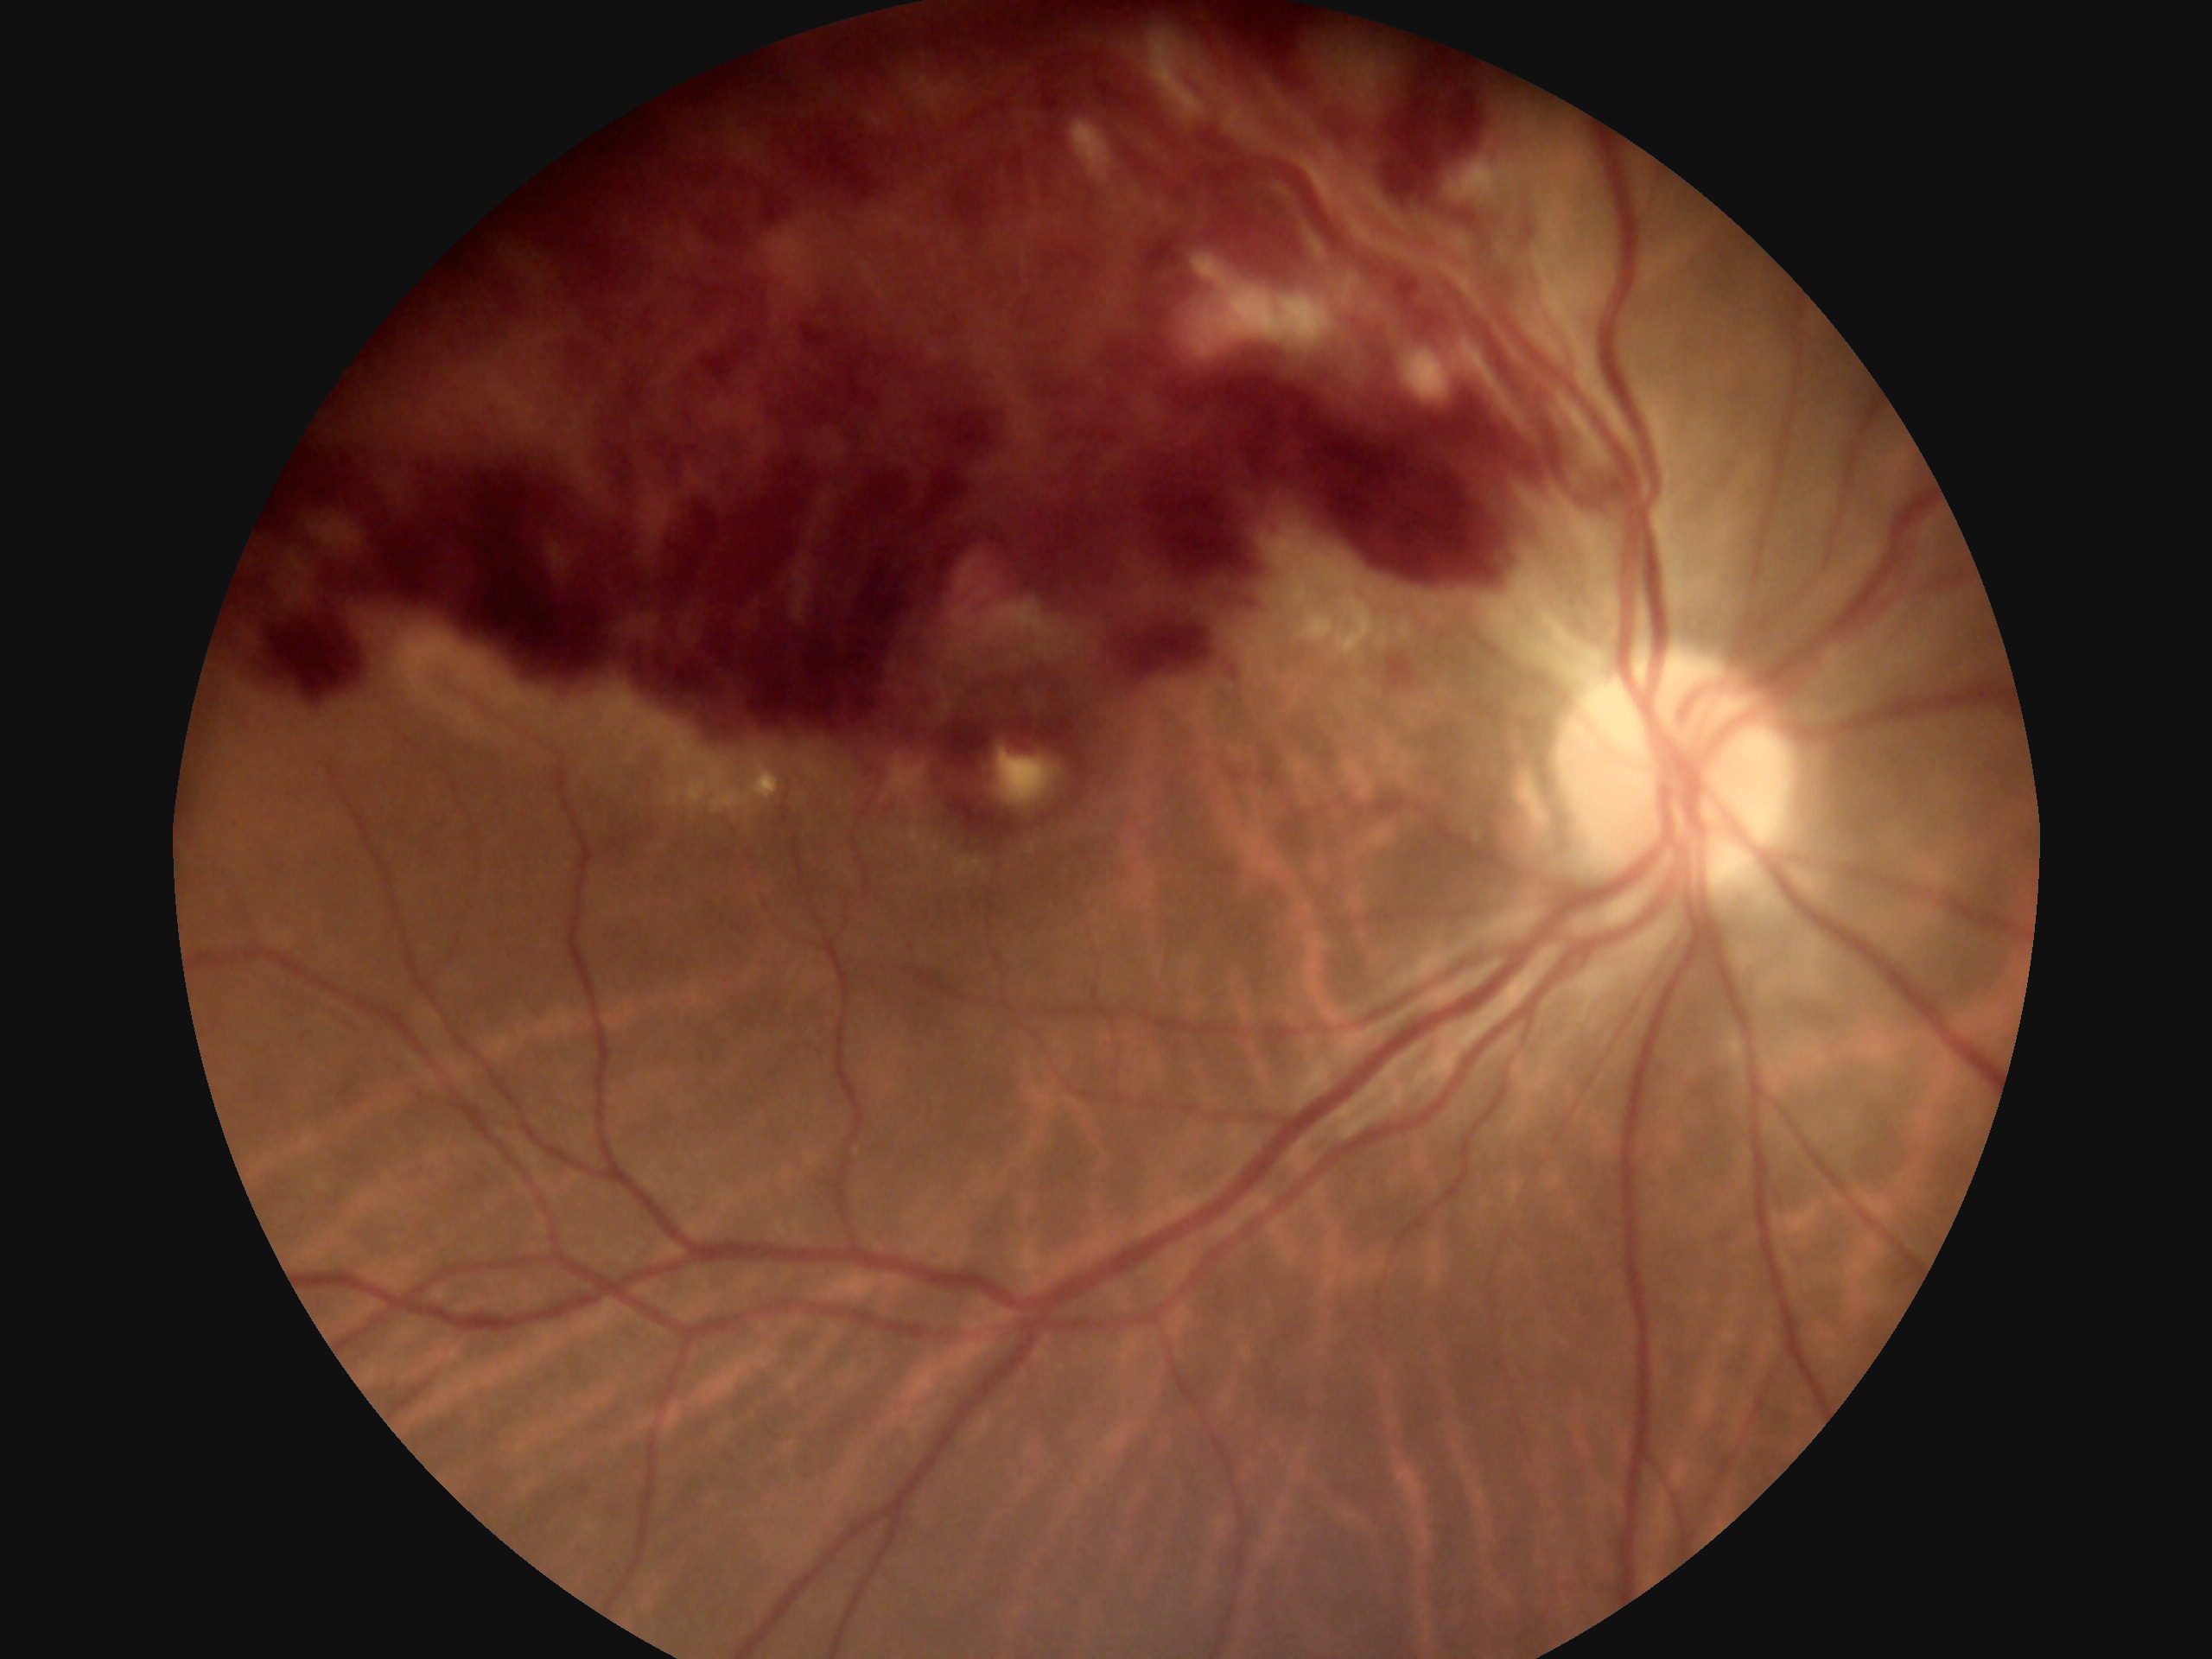

DR severity@grade 4 (PDR).